Diabetic retinopathy graded by the modified Davis classification — 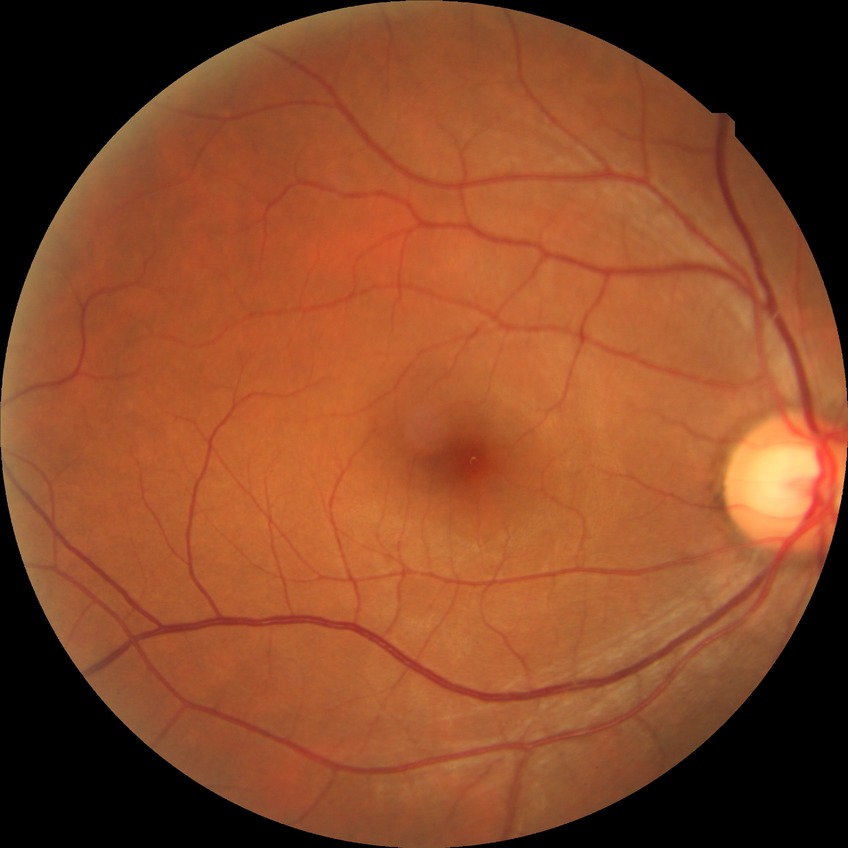 Davis stage is NDR.